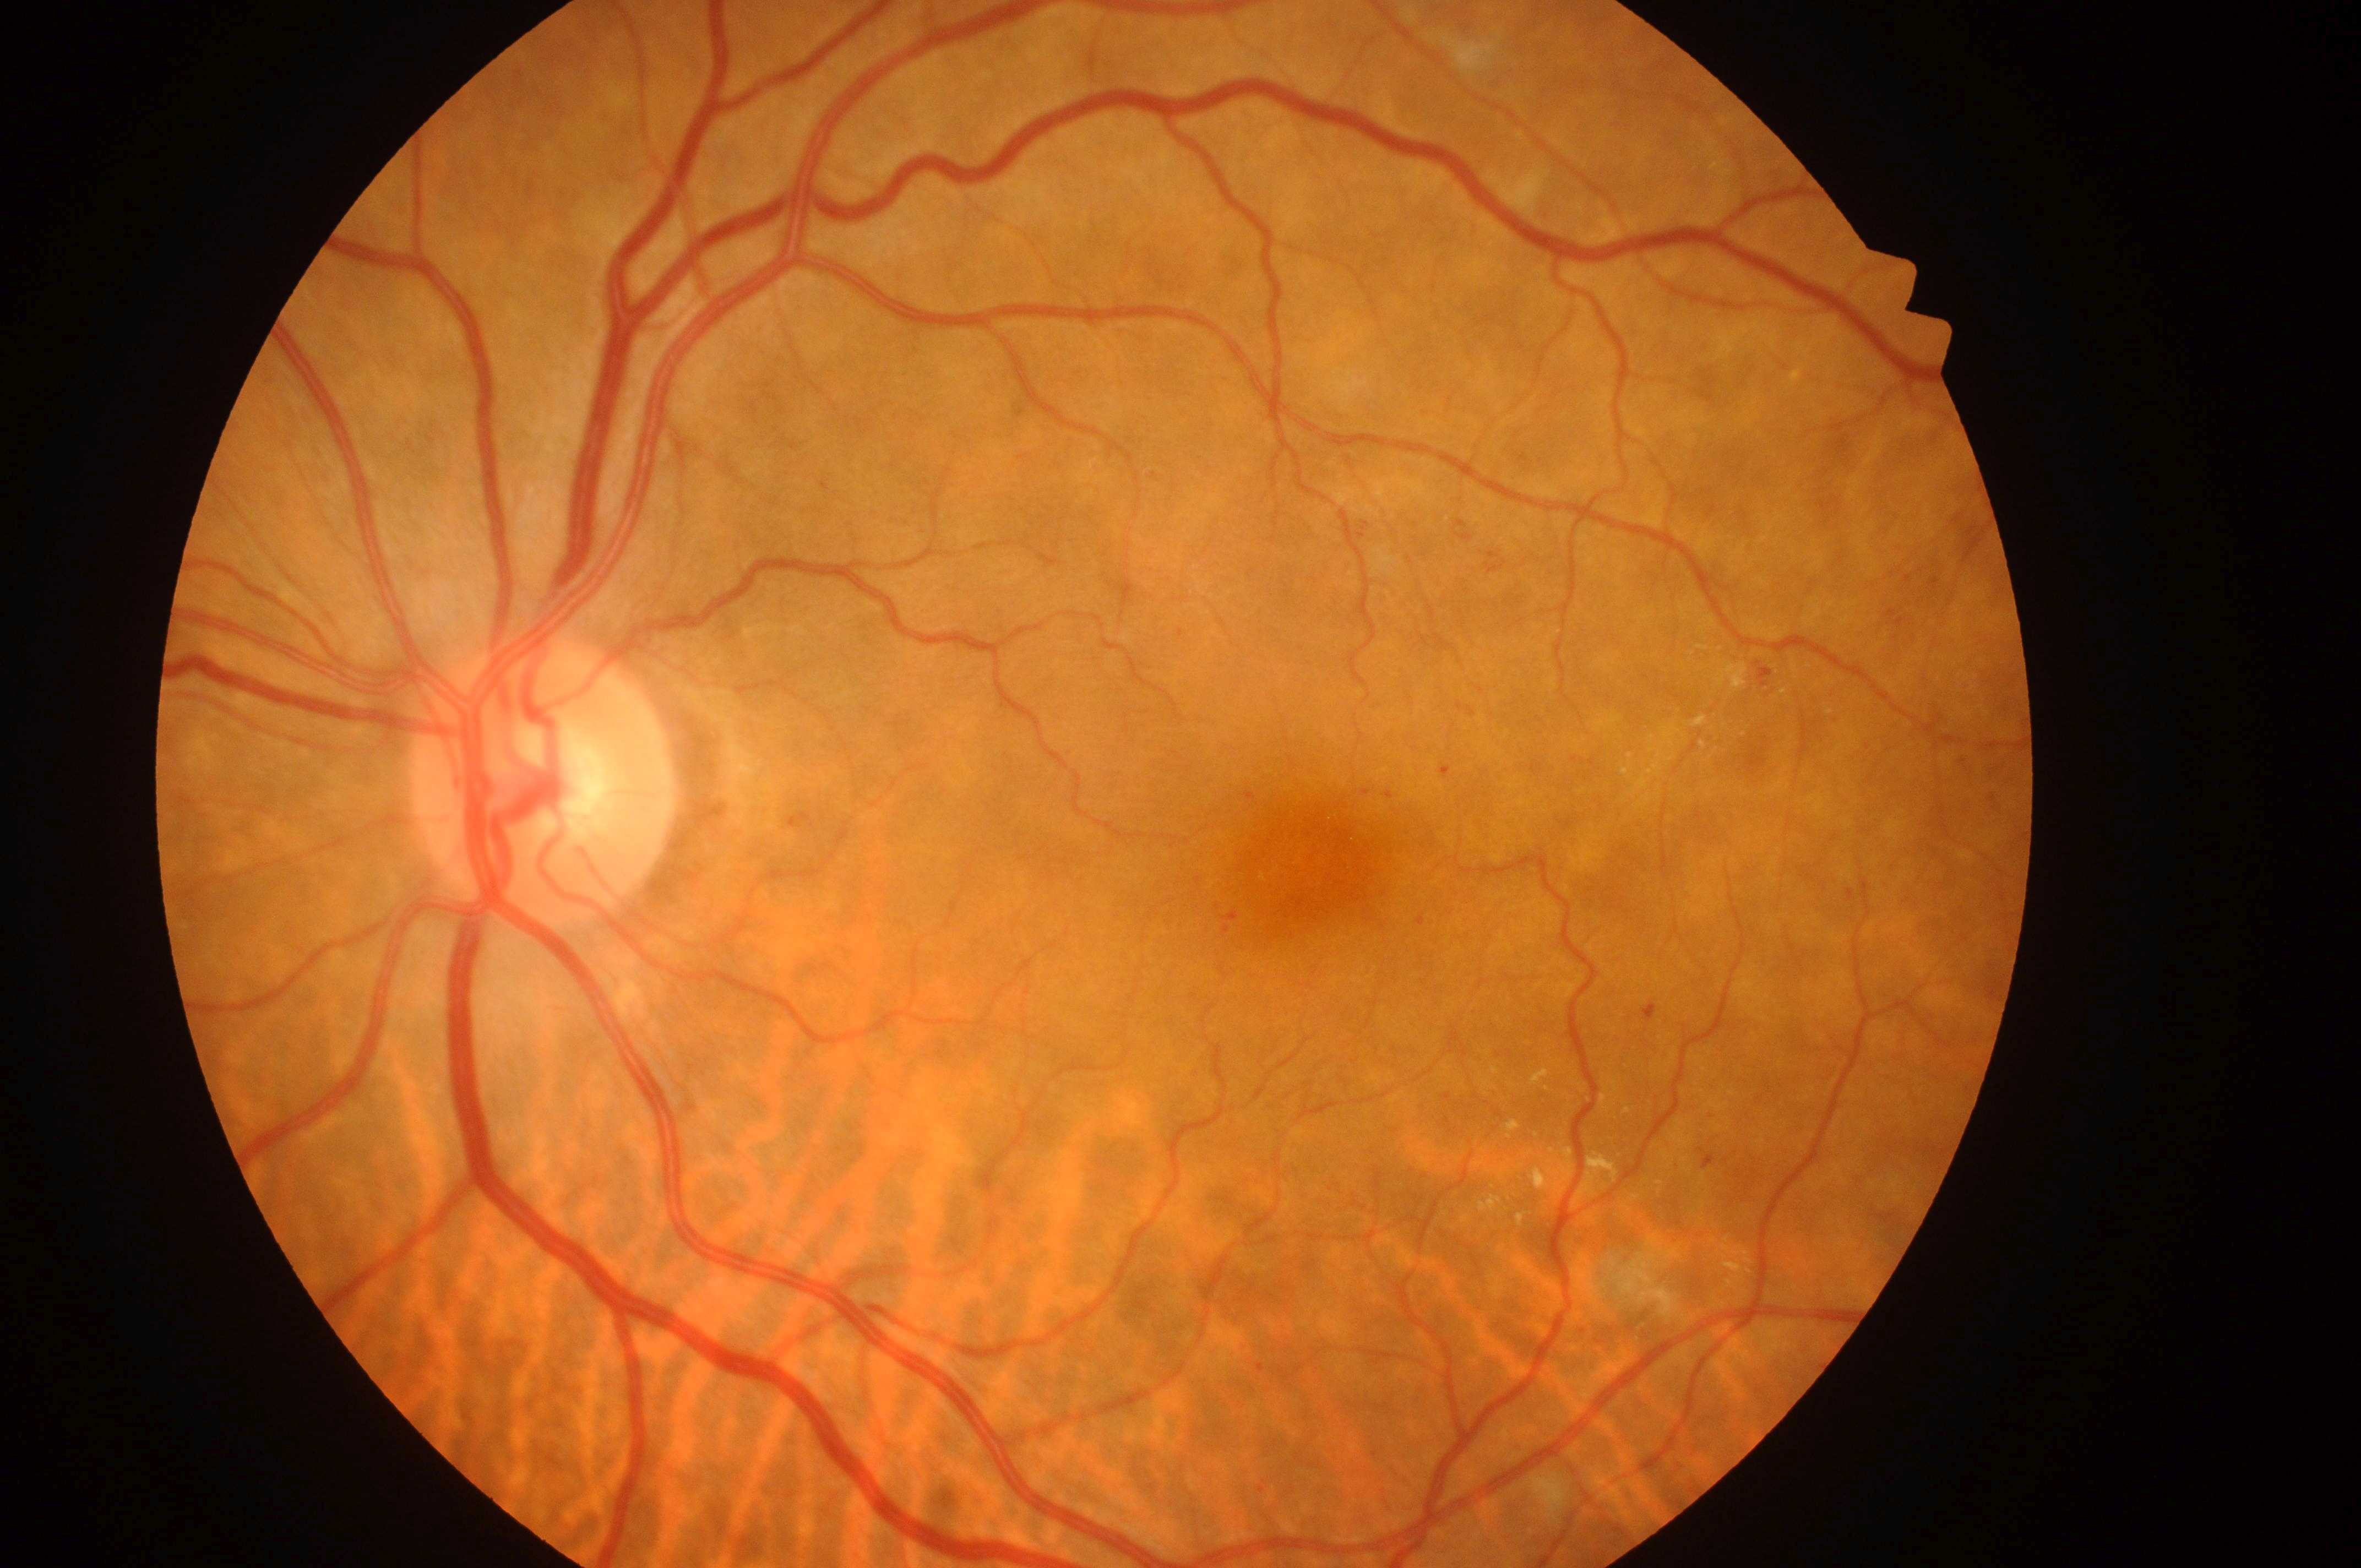

{"fovea": "(1318,876)", "dr_category": "non-proliferative diabetic retinopathy", "eye": "left eye", "optic_disc": "(542,793)", "dme_grade": "low risk (1)", "dr_grade": "2 (moderate NPDR)"}